Nonmydriatic, image size 848x848, posterior pole photograph:
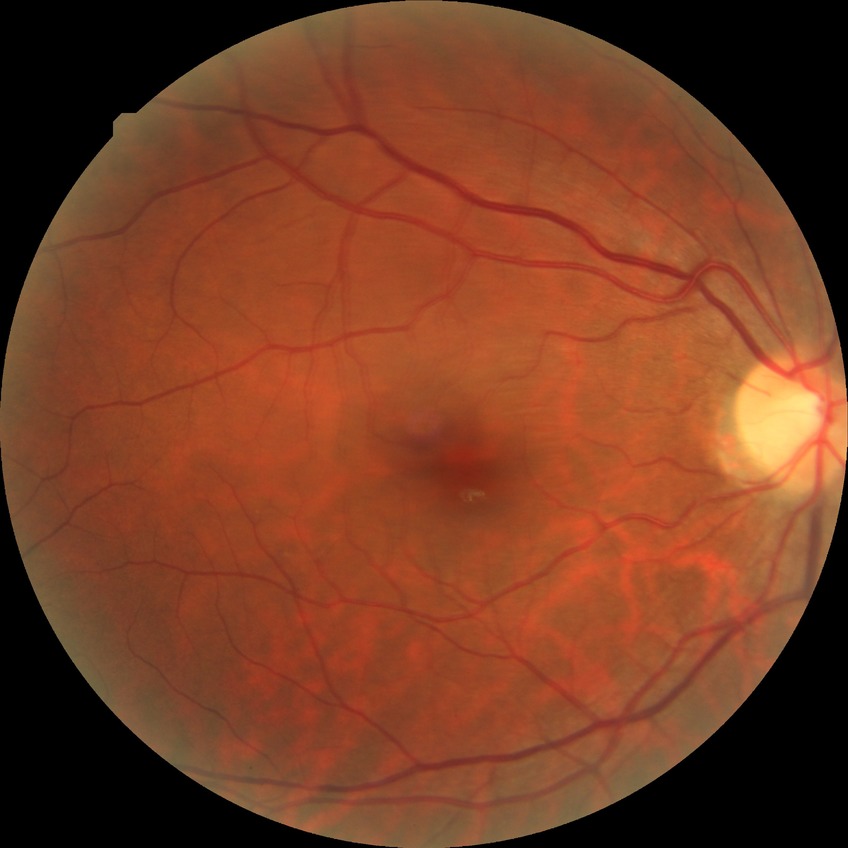
Davis DR grade is NDR.